Retinal fundus photograph:
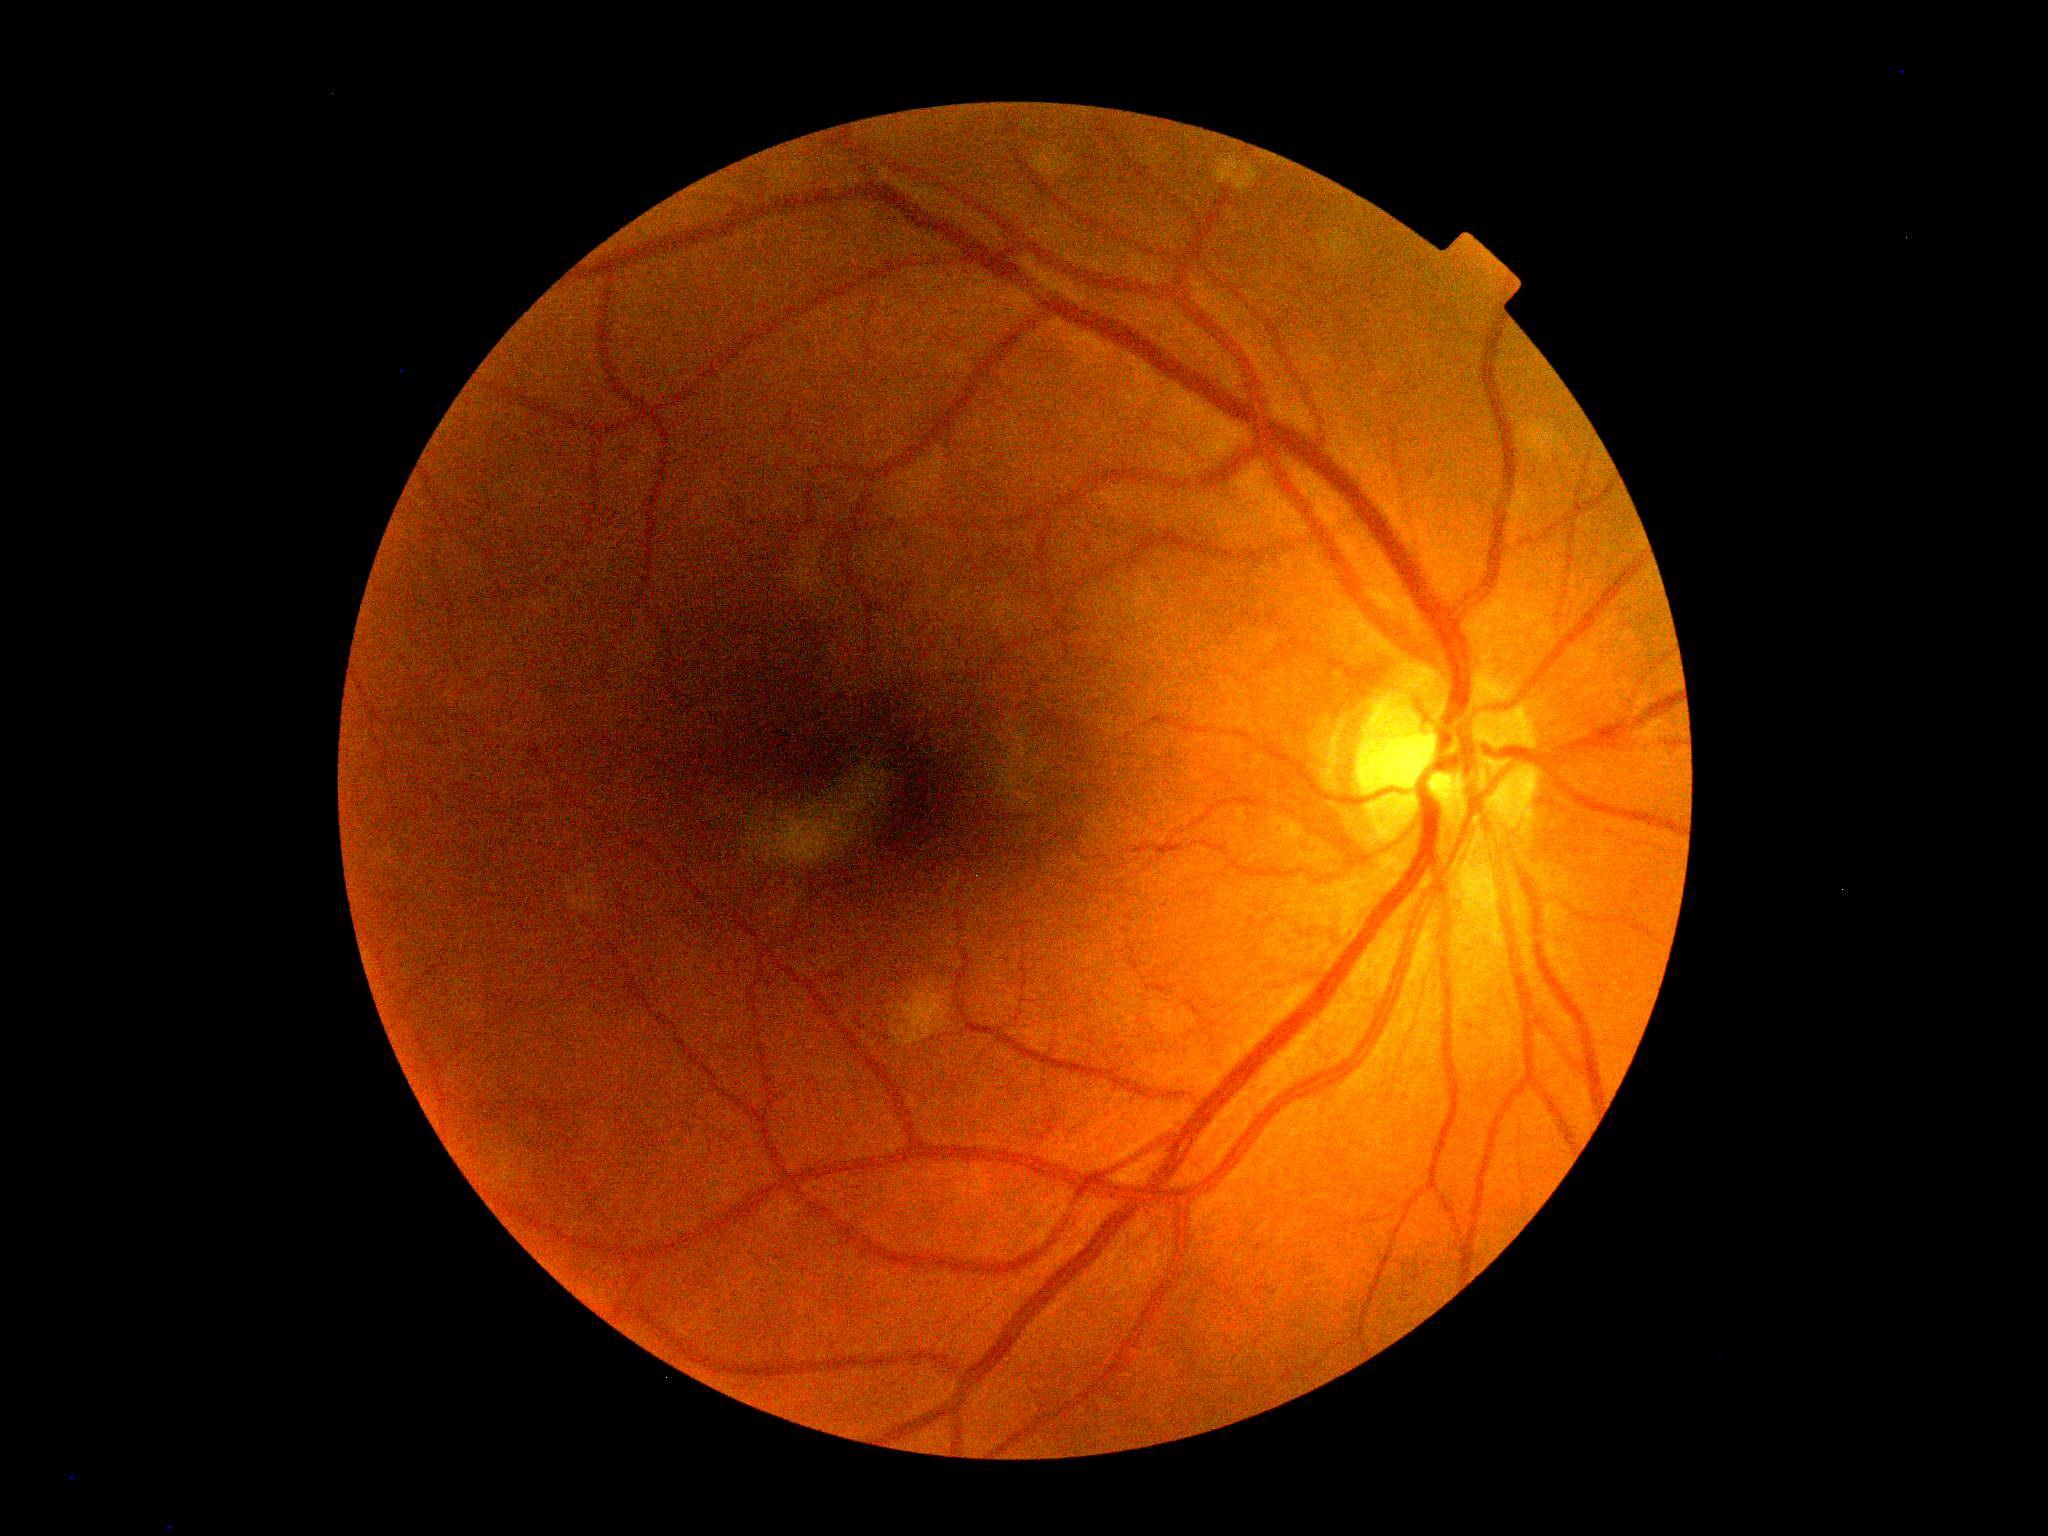

DR grade: 0 (no apparent retinopathy).